FOV: 45 degrees · retinal fundus photograph — 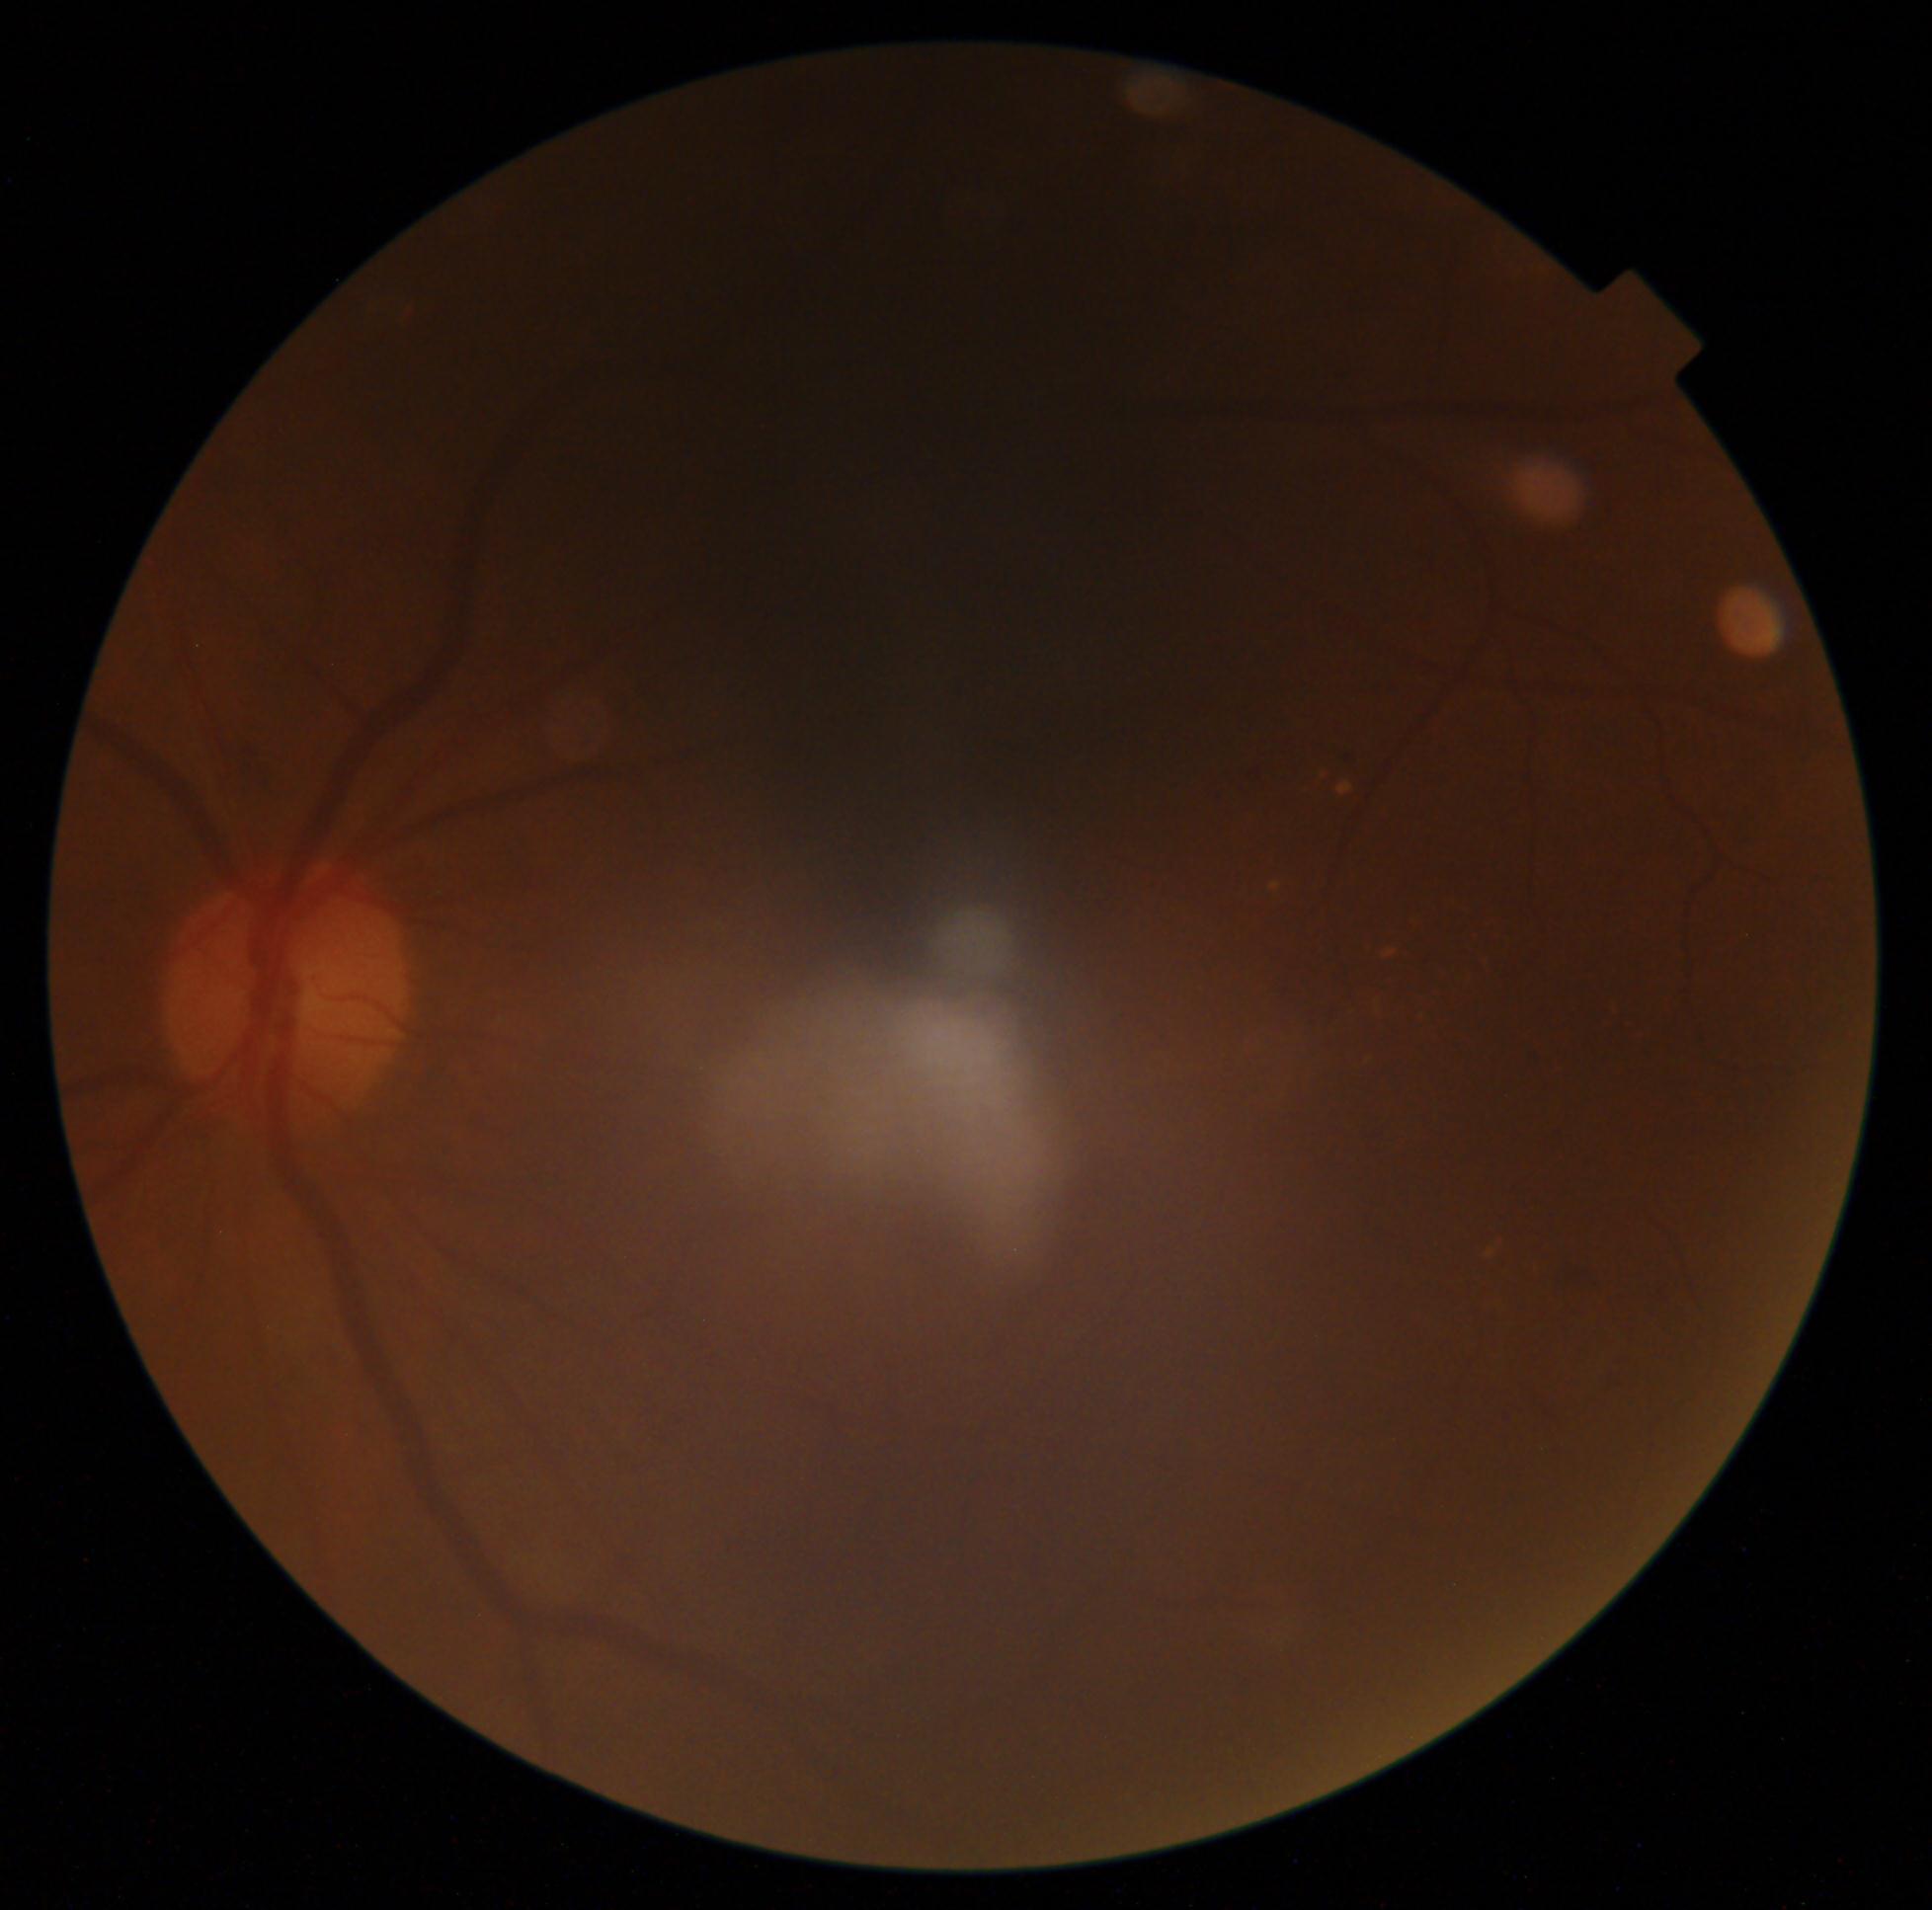 Diabetic retinopathy severity: 2/4.